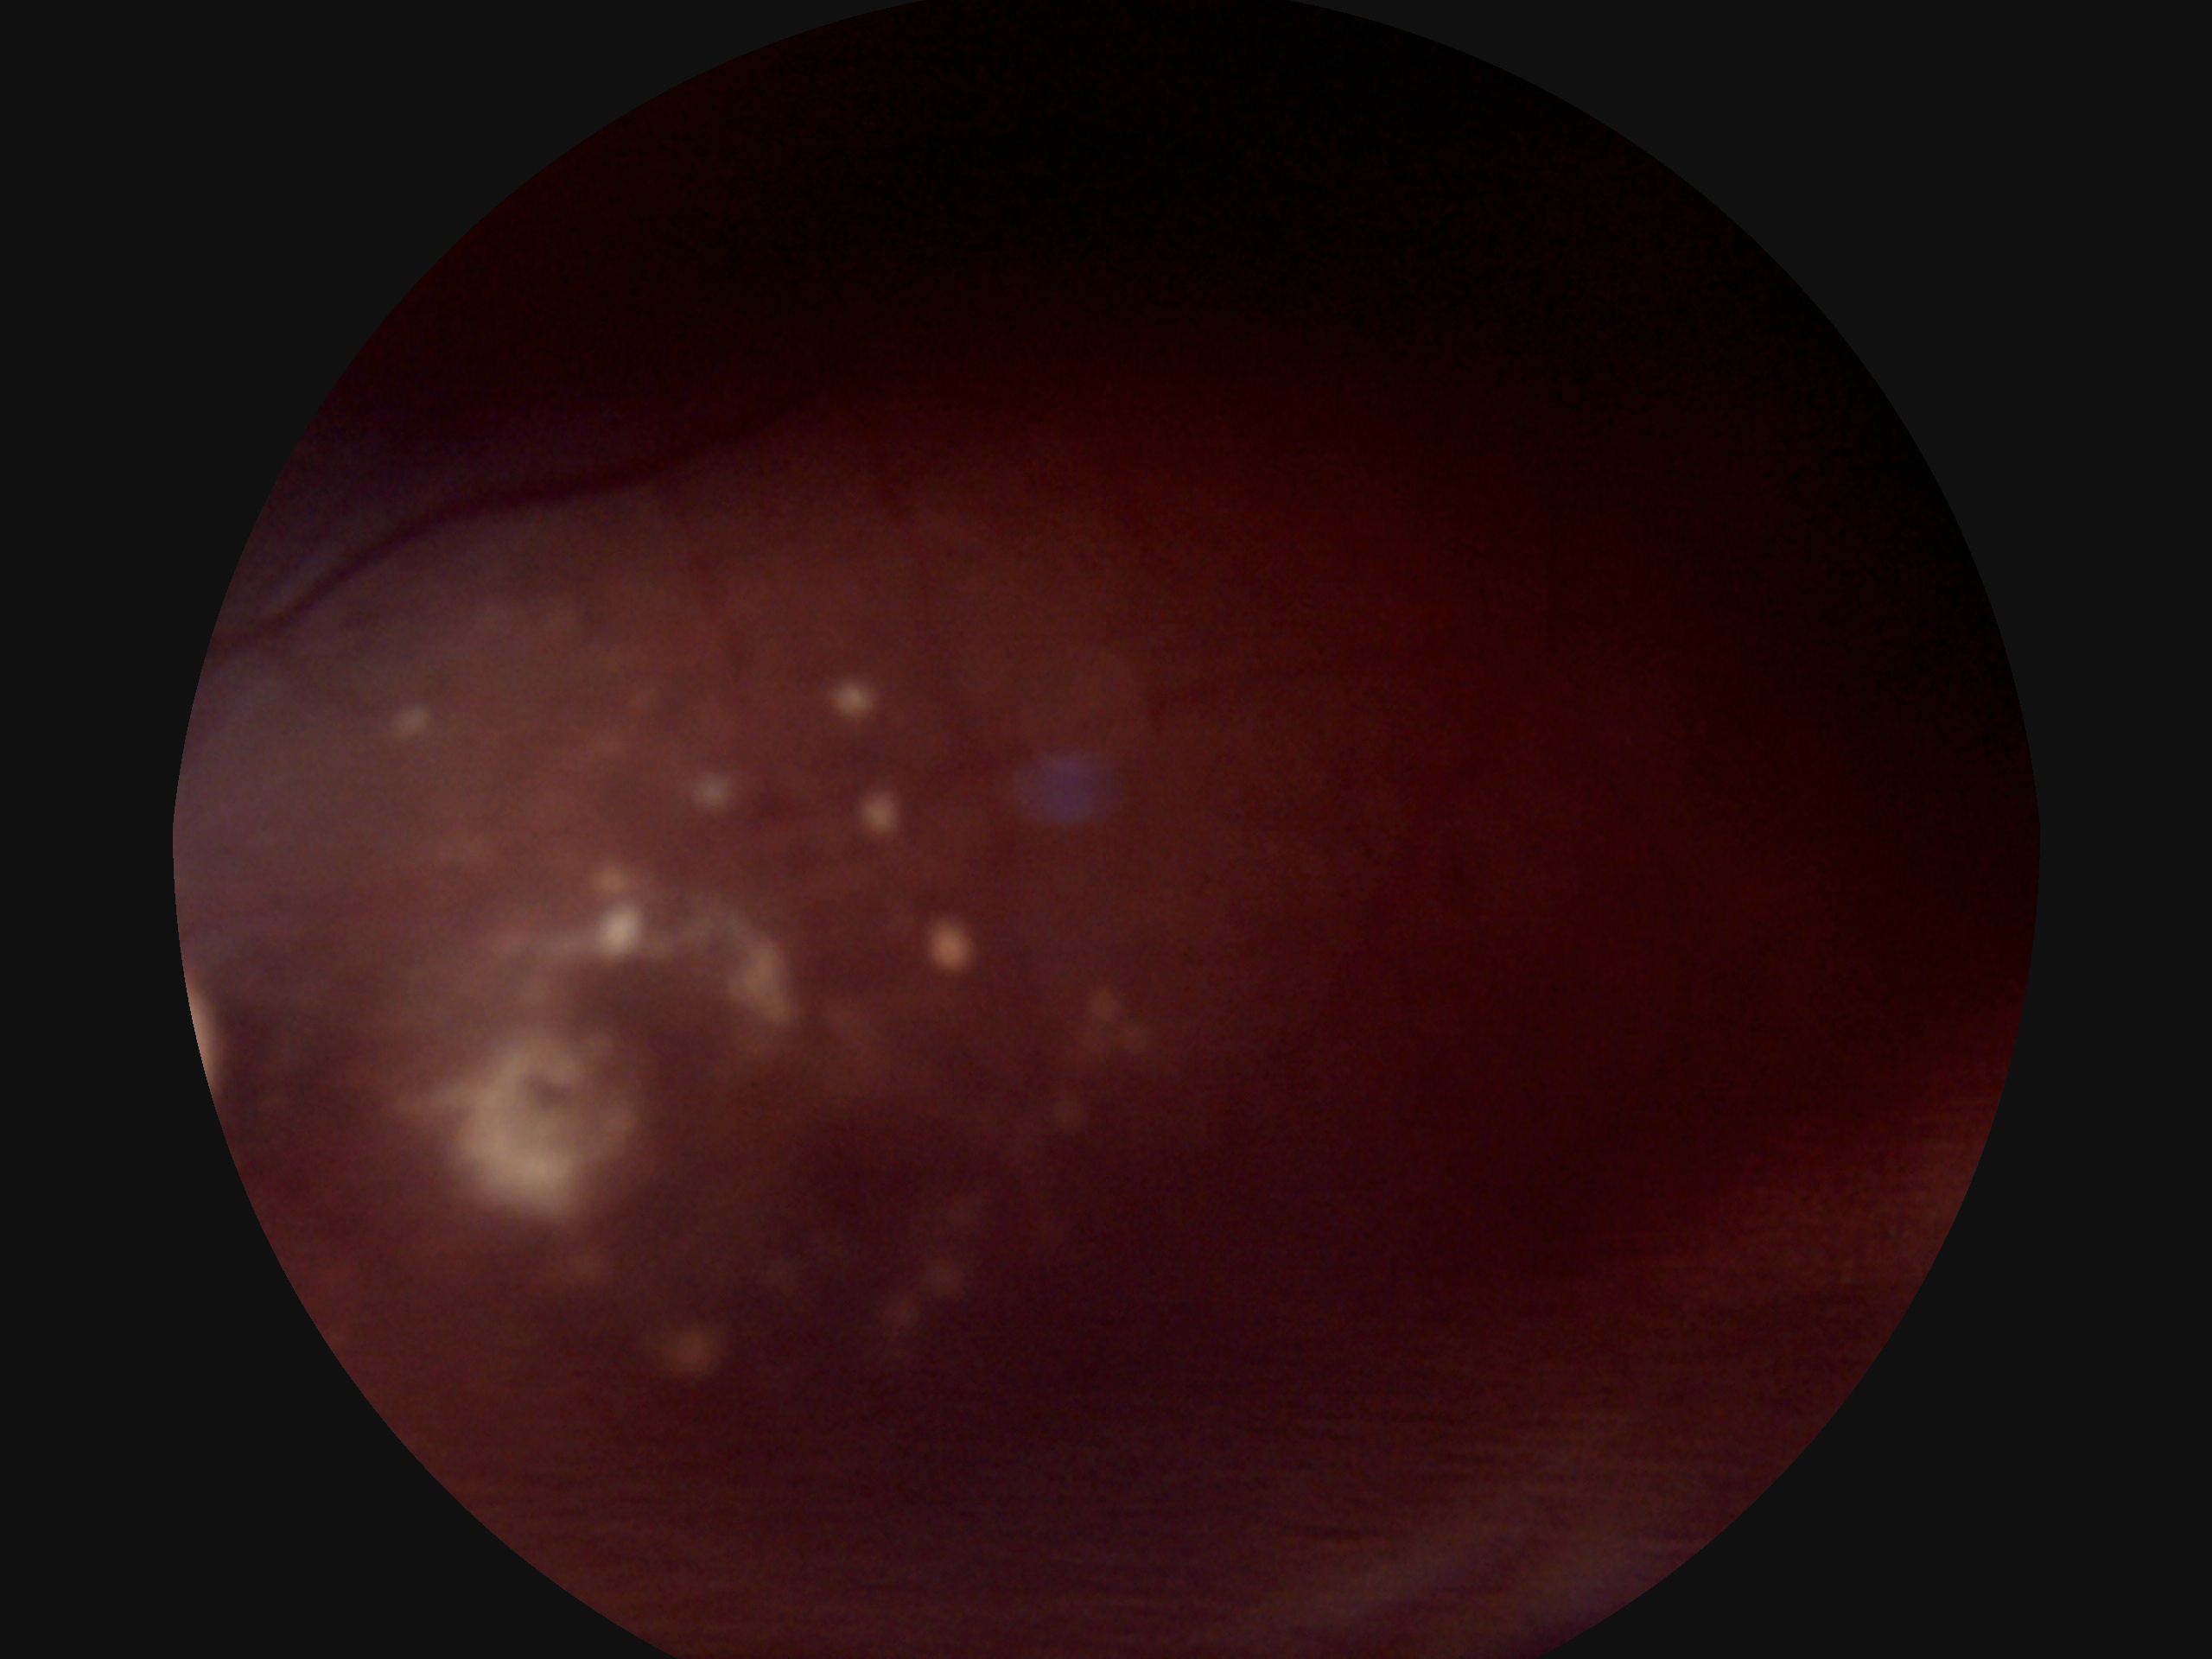 {
  "dr_grade": "ungradable",
  "quality": "insufficient for DR assessment"
}